2184 by 1682 pixels
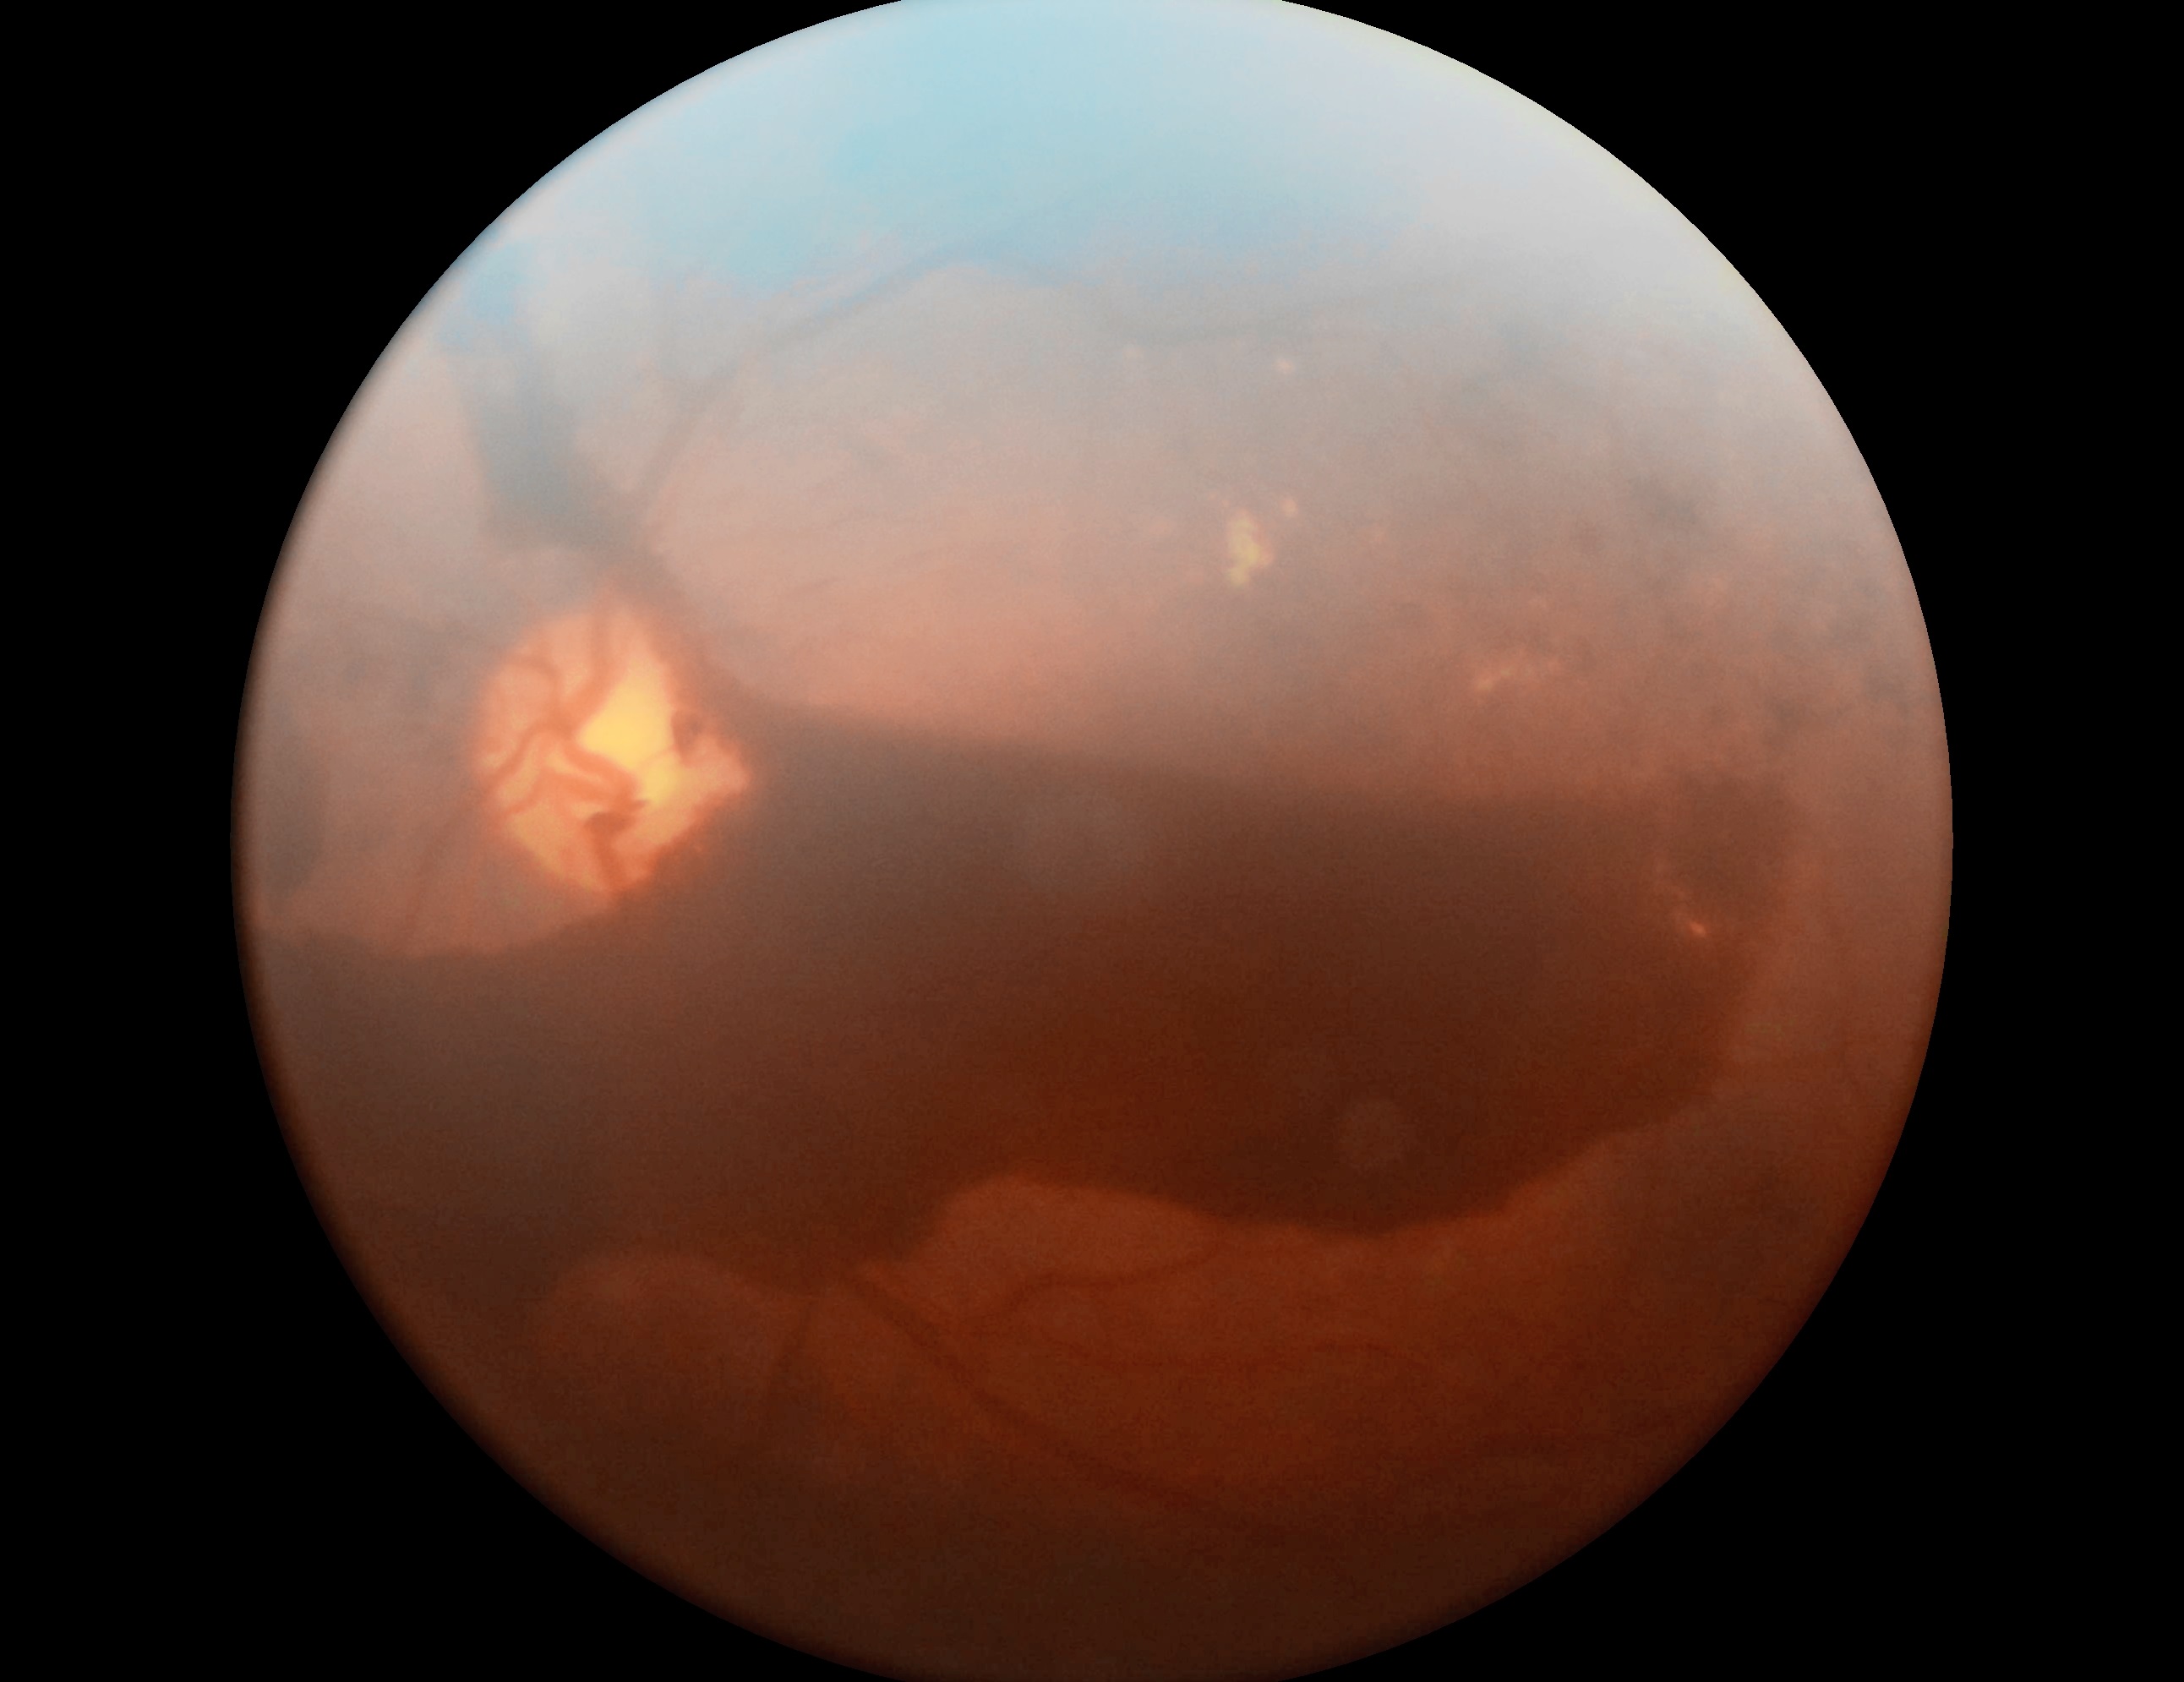

DR class: proliferative diabetic retinopathy.
Retinopathy grade: PDR (4).